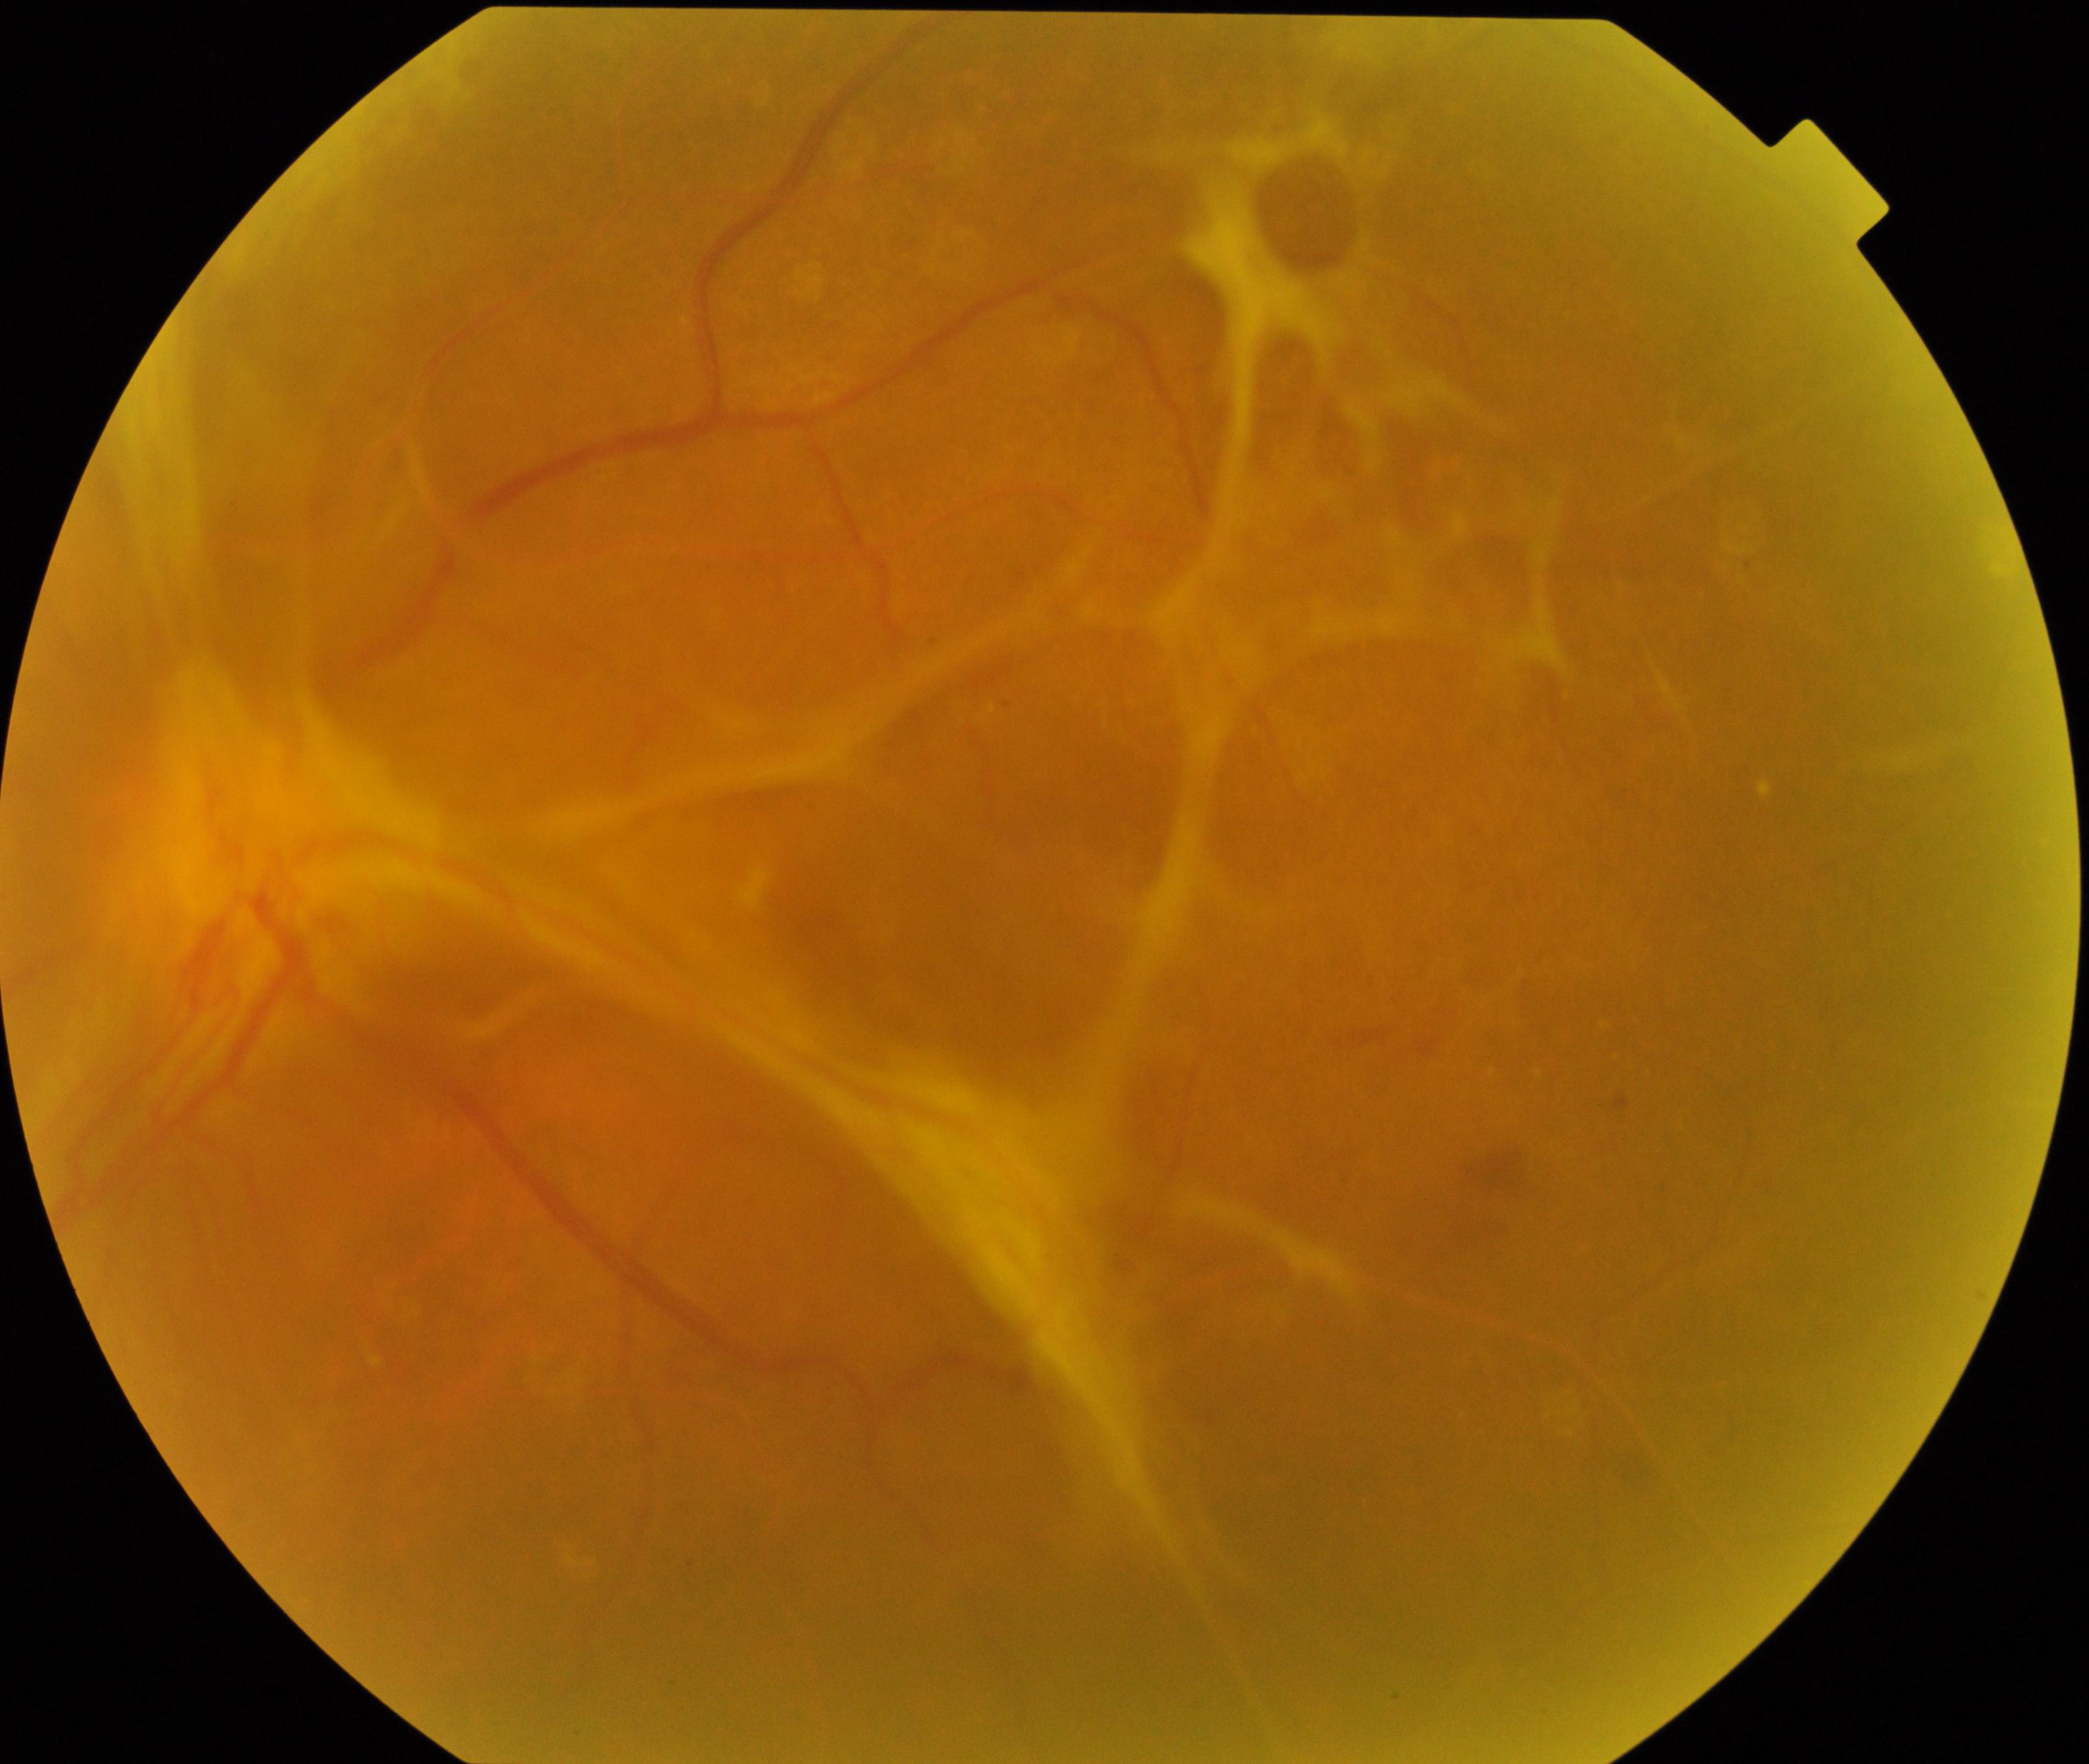
Demonstrates fibrosis.